Wide-field retinal mosaic image:
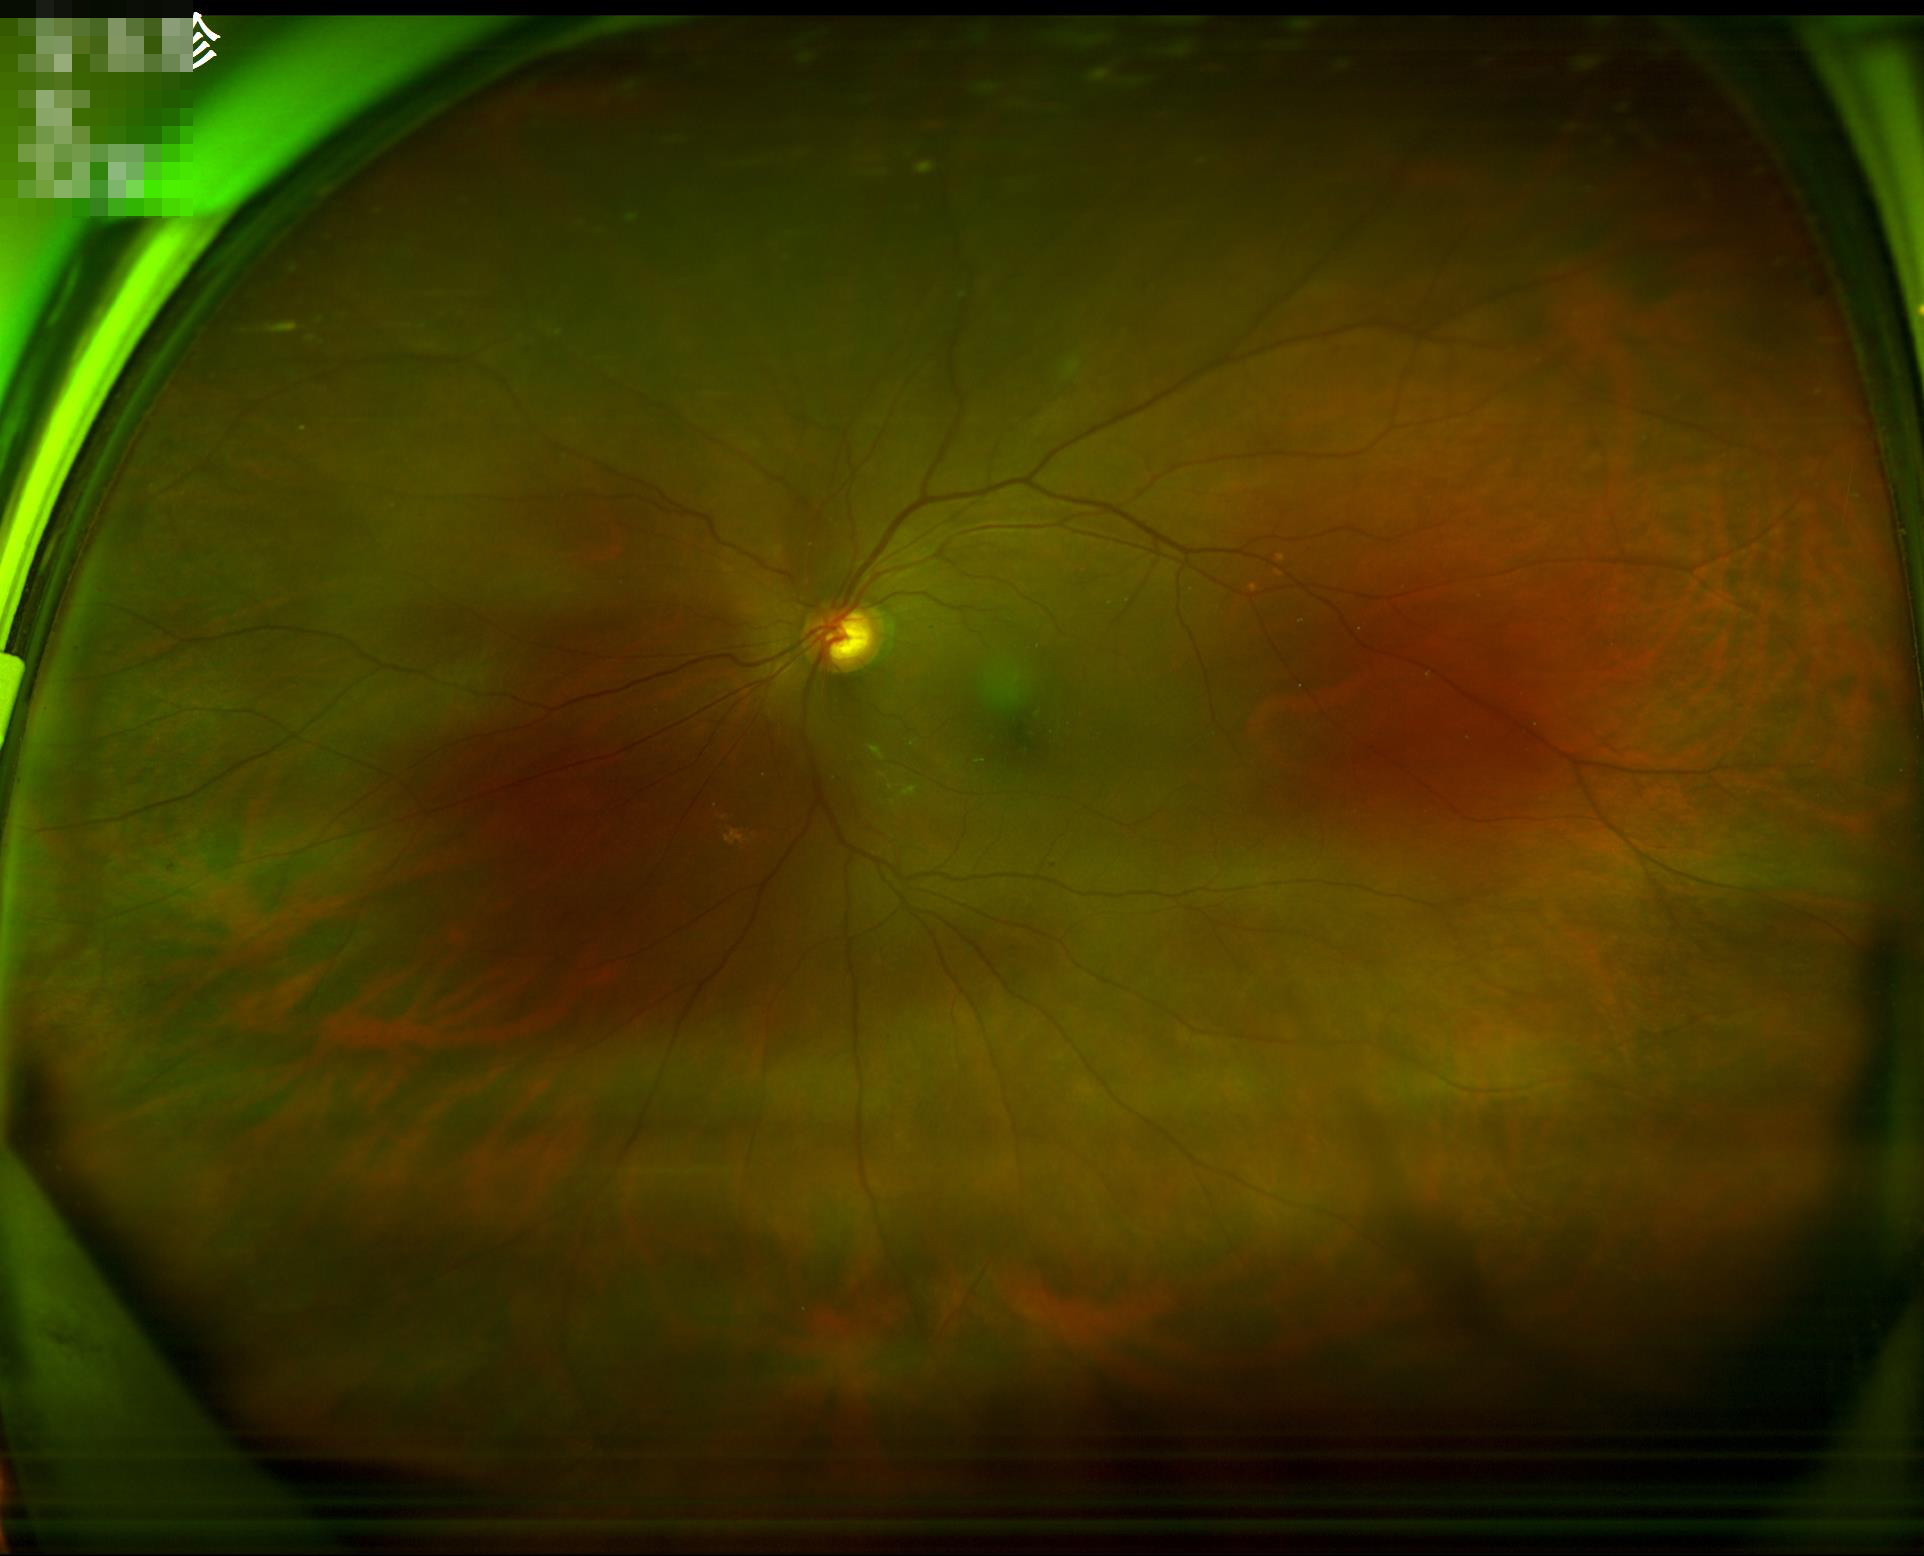 Focus = sharp throughout the field
Illumination = even and well-balanced